Mydriatic, 370 x 370 pixels, fundus photograph cropped around the optic nerve head.
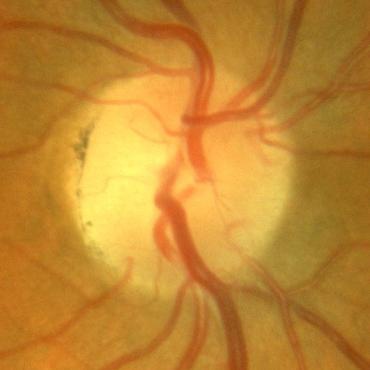

No glaucomatous damage.